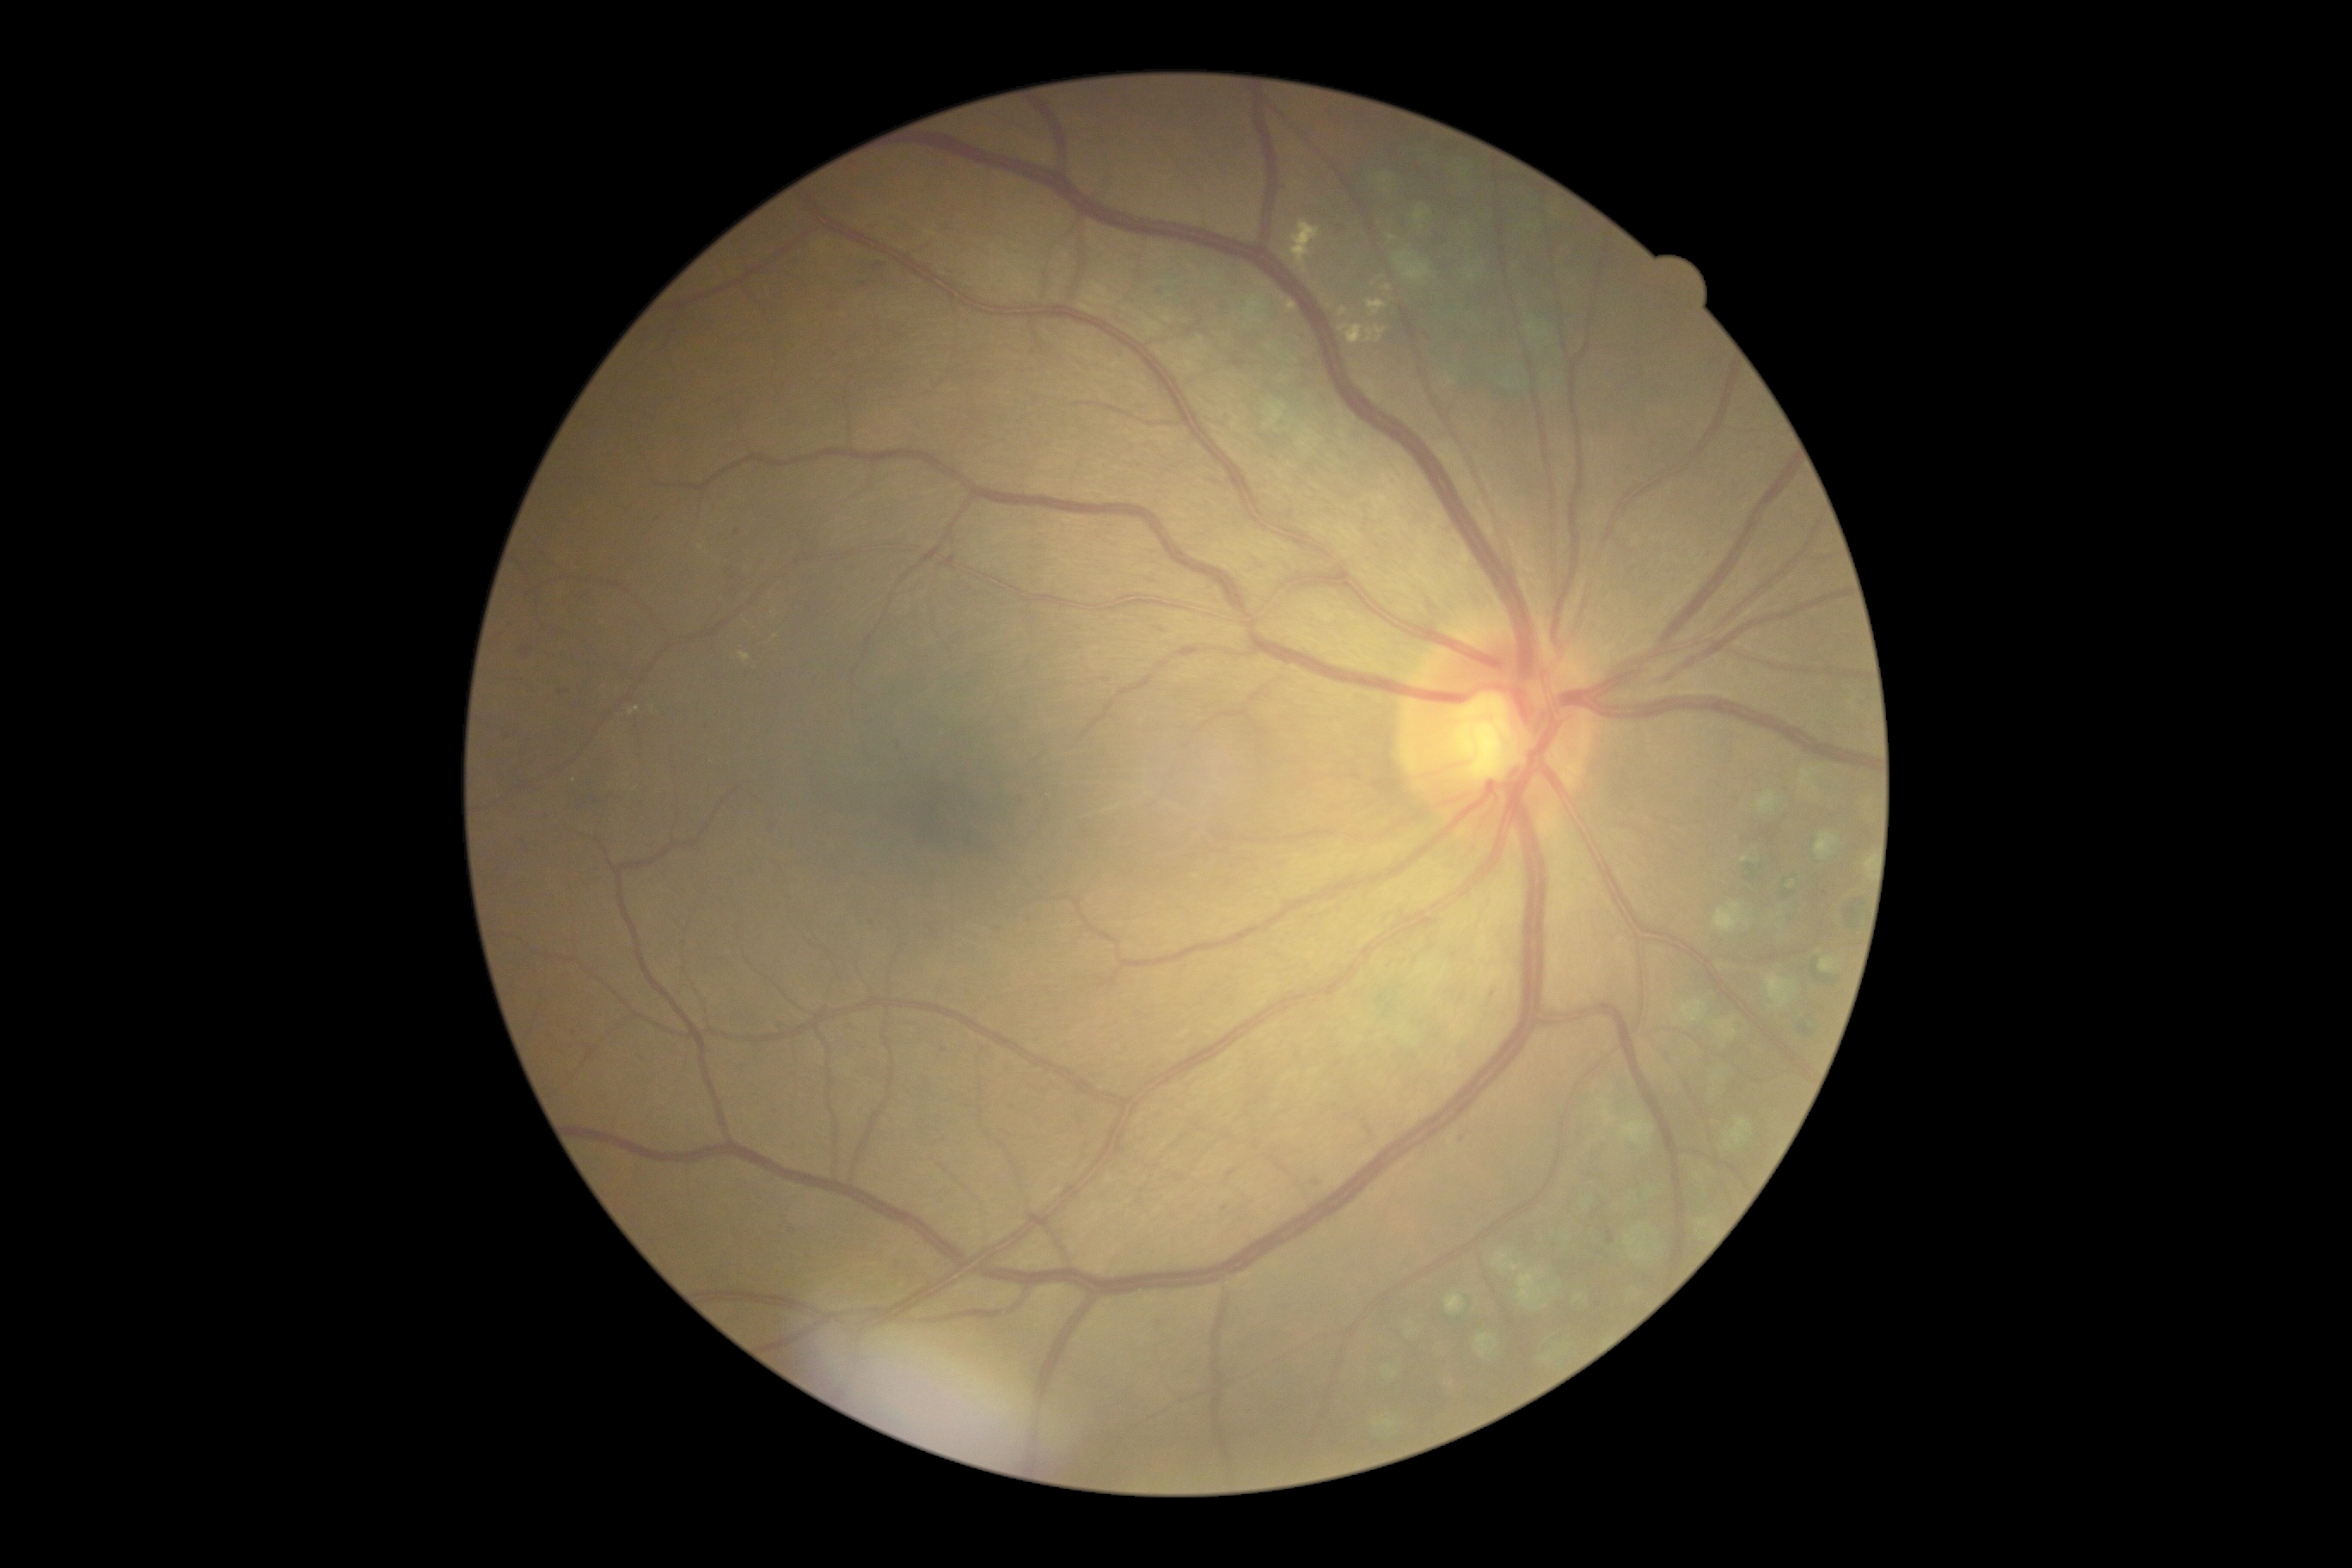

diabetic retinopathy (DR): grade 2 (moderate NPDR).